Color fundus photograph, diabetic retinopathy graded by the modified Davis classification — 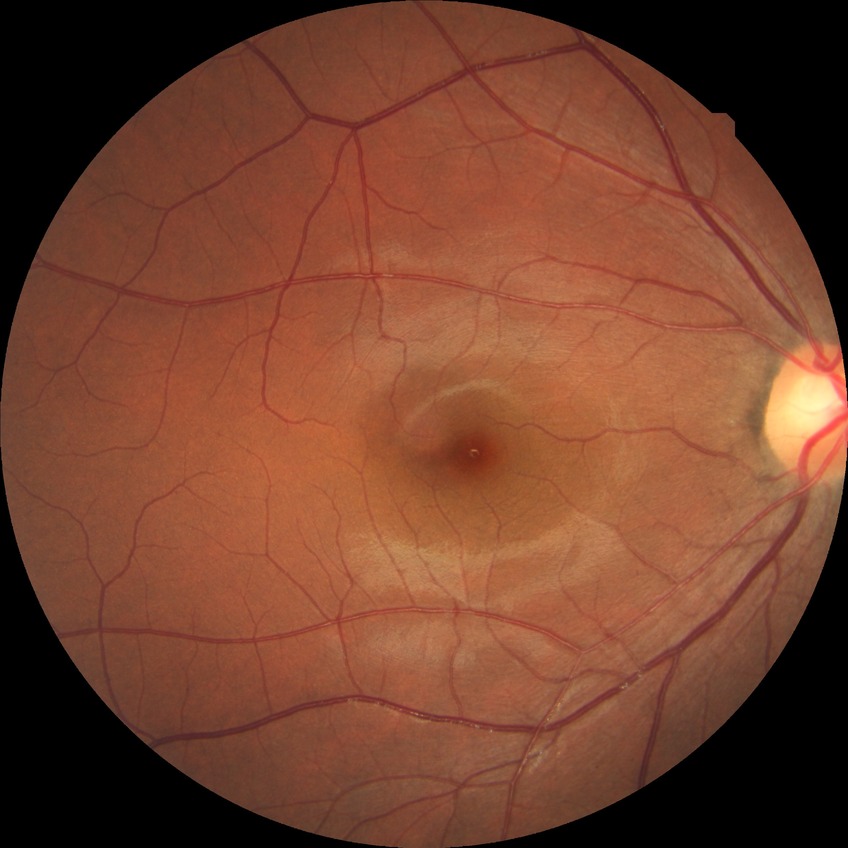 Assessment:
• diabetic retinopathy stage: no diabetic retinopathy